Wide-field fundus image from infant ROP screening: 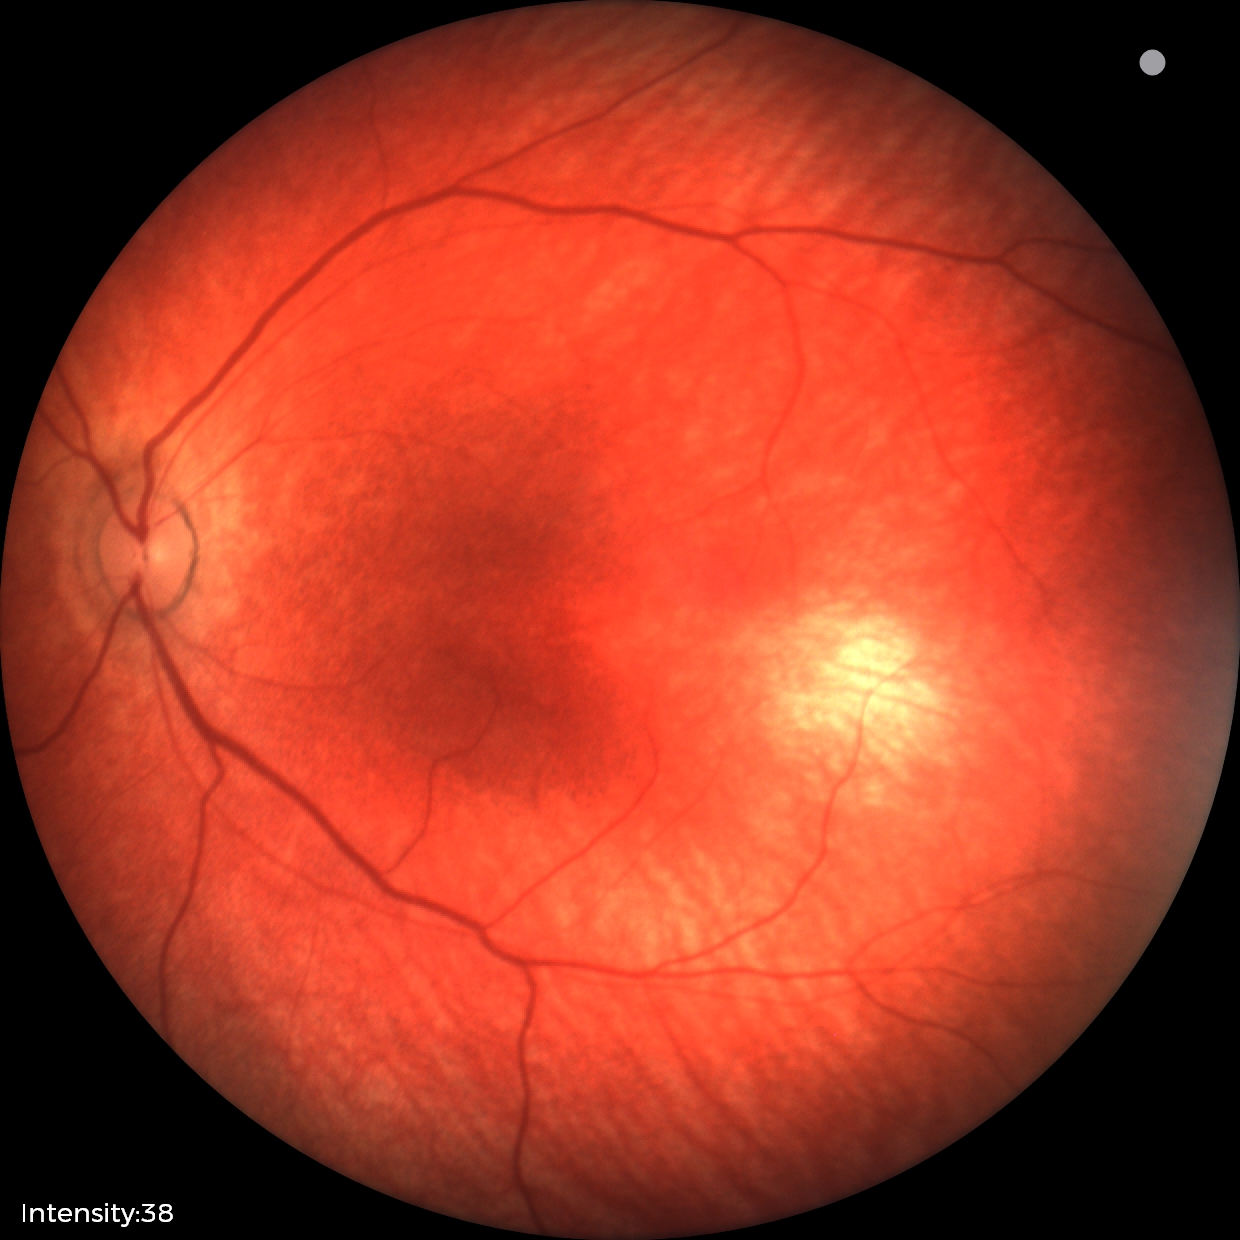

No retinal pathology identified on screening.